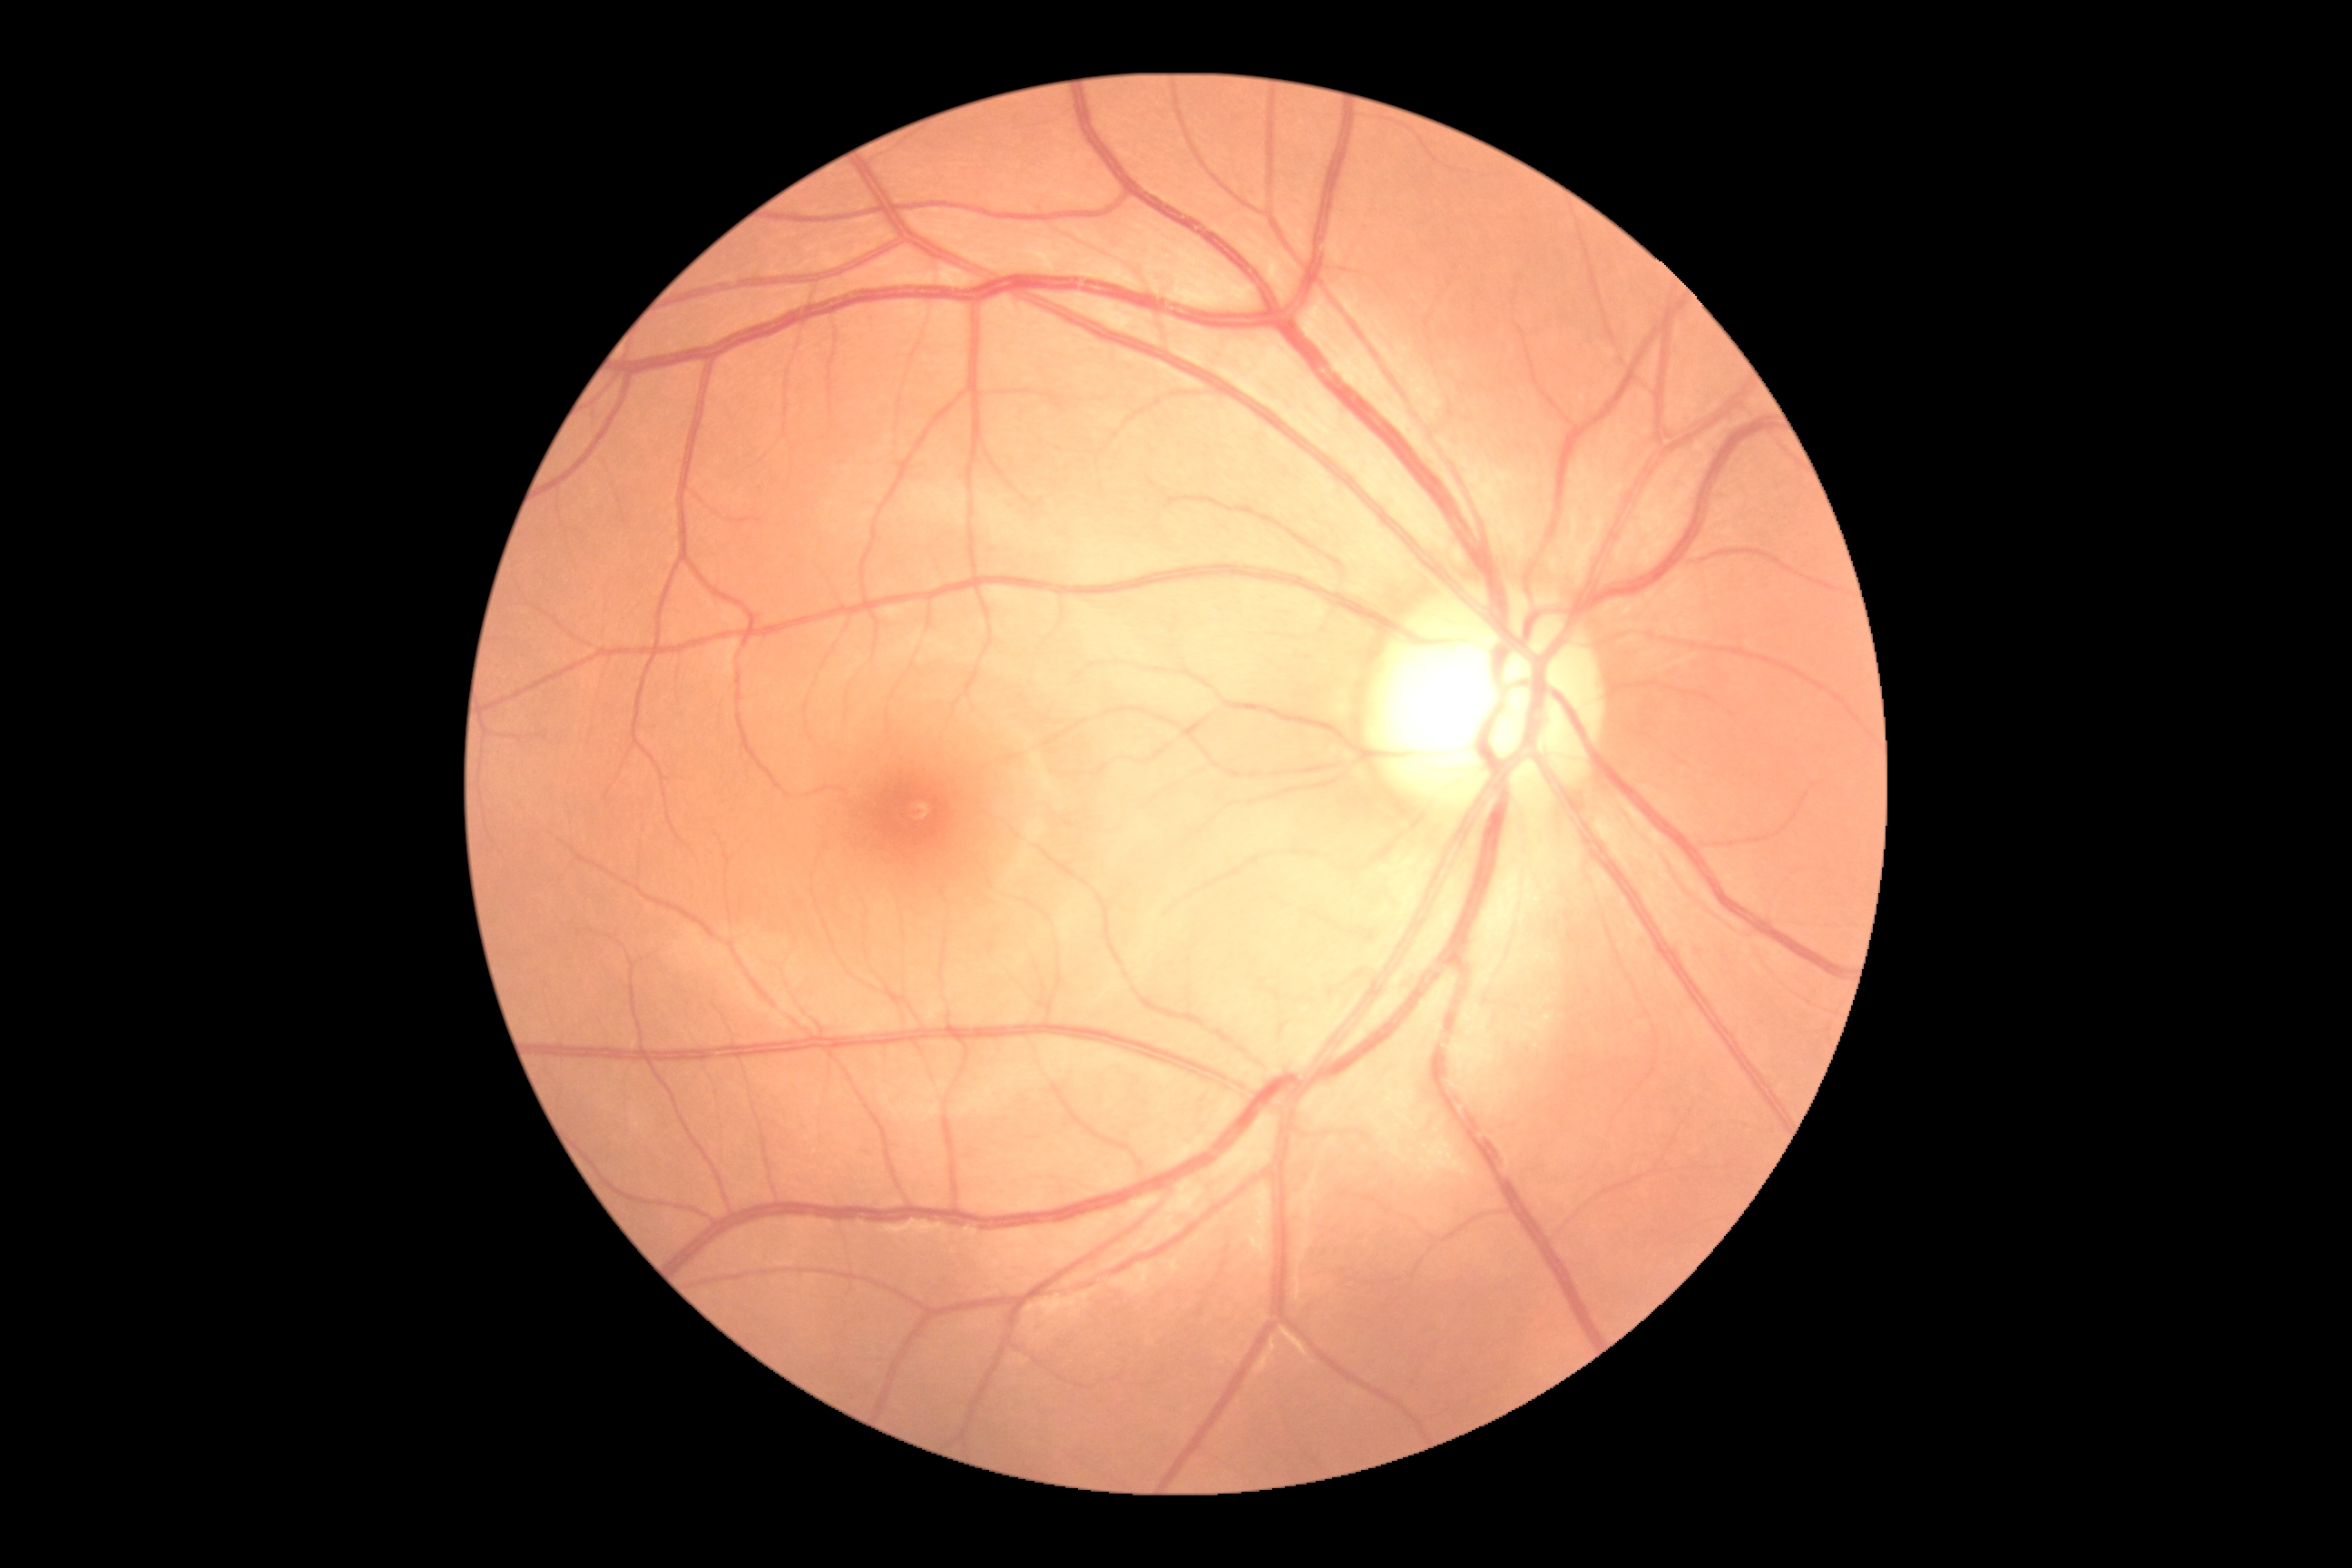 Retinopathy: no apparent diabetic retinopathy (grade 0). No DR findings.